Image size 848x848.
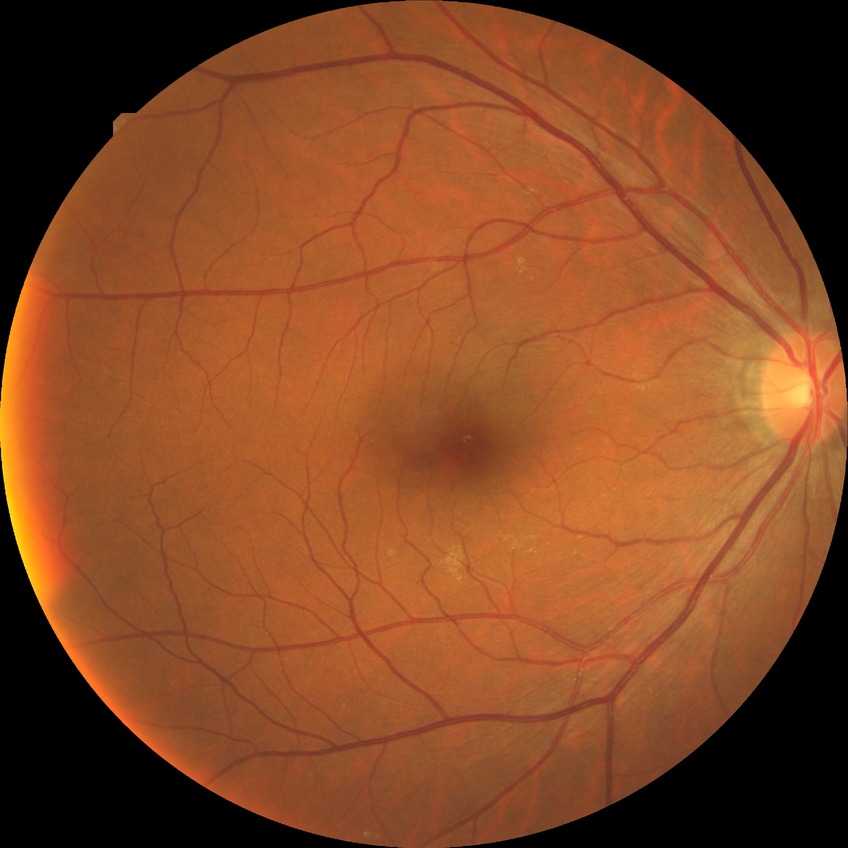
Diabetic retinopathy (DR) is no diabetic retinopathy (NDR).